Davis DR grading, 848 x 848 pixels, 45 degree fundus photograph
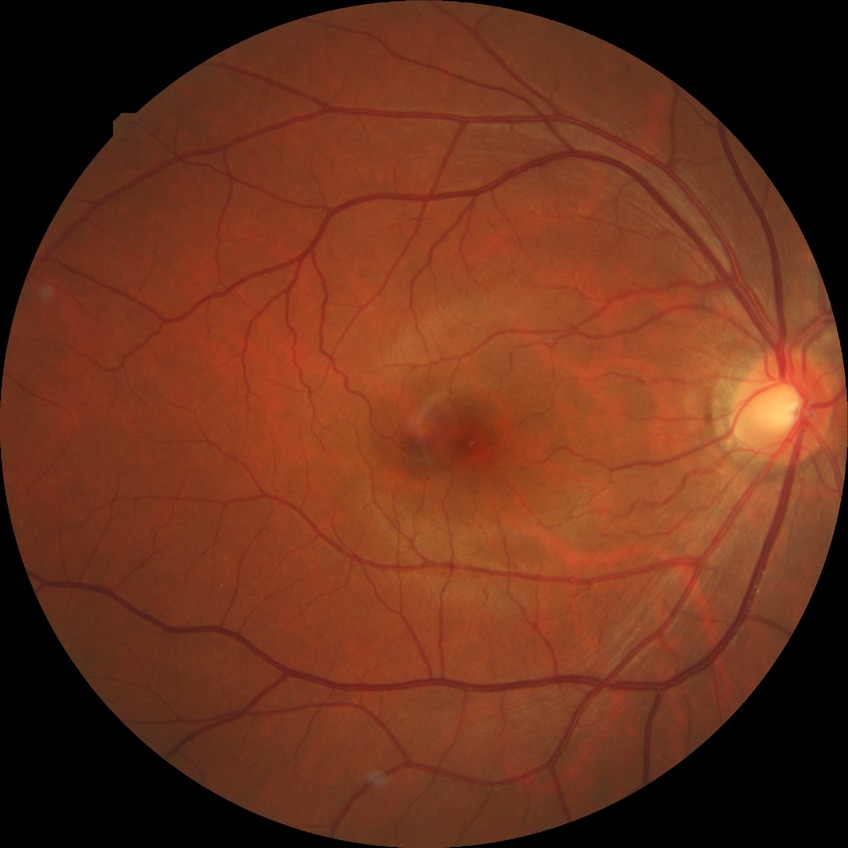
{
  "davis_grade": "NDR",
  "dr_impression": "no signs of DR"
}